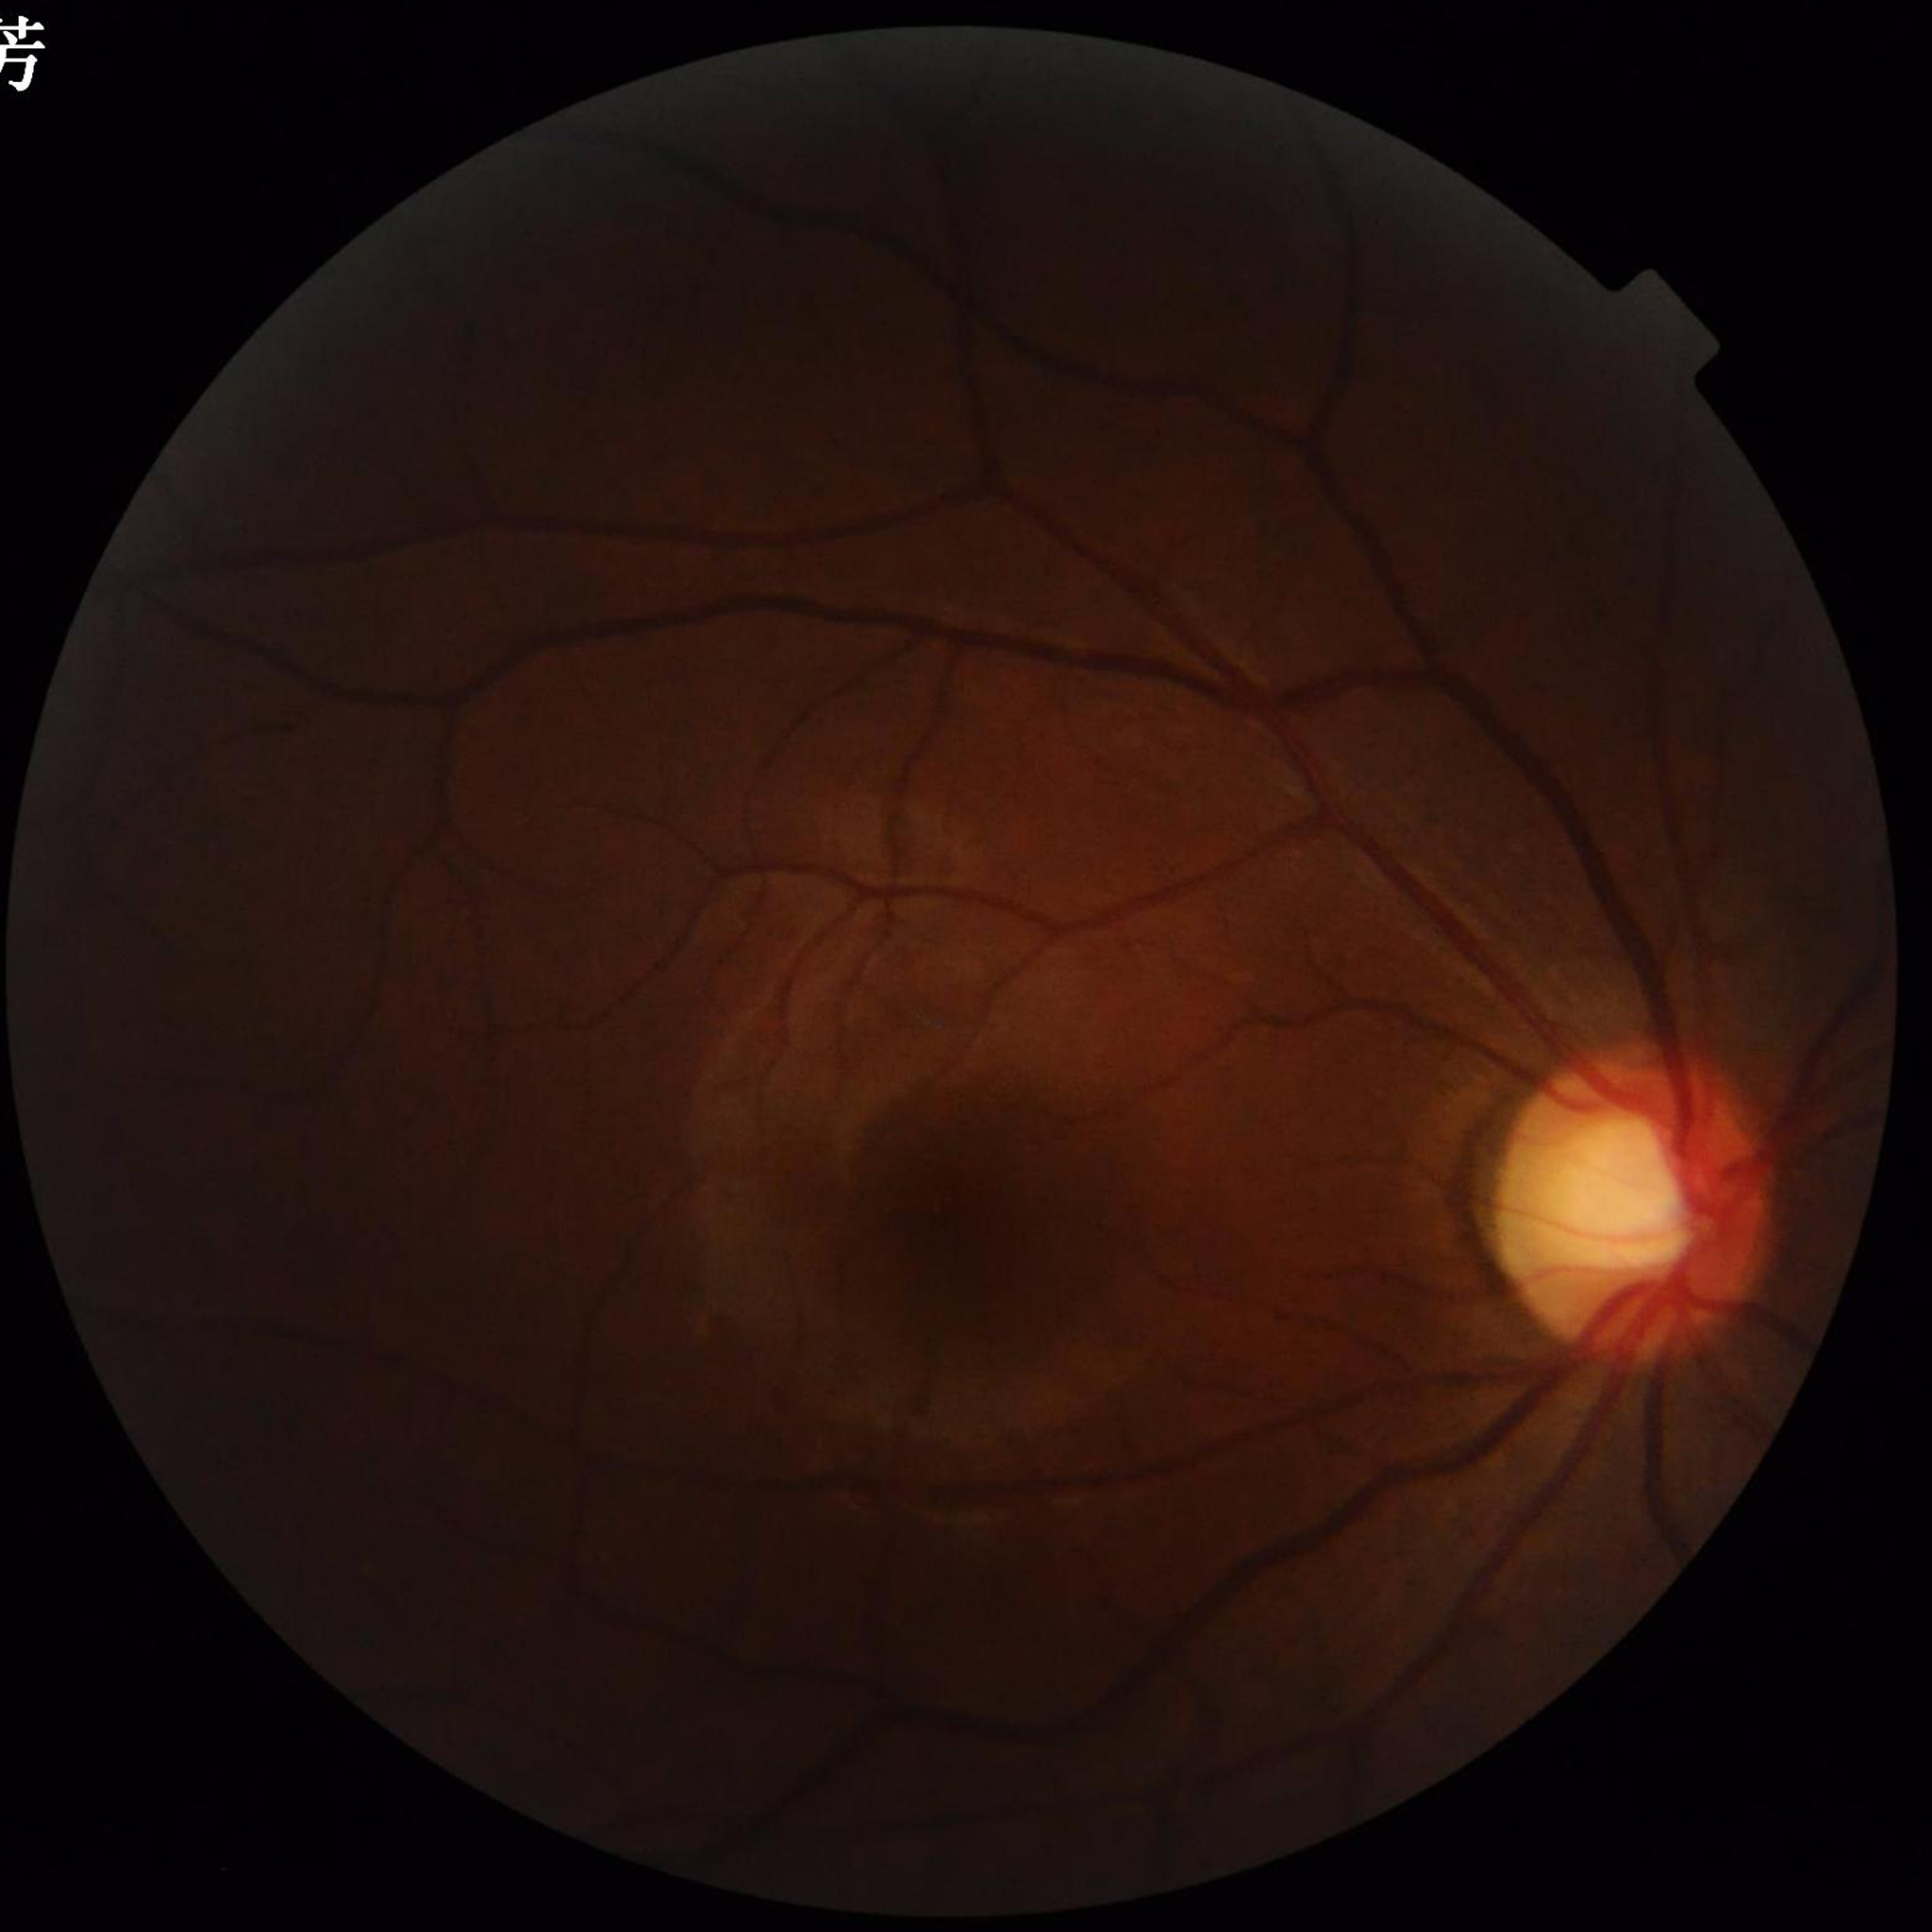
Automated quality assessment: poor — illumination/color distortion.
From a patient with glaucoma.